Color fundus image, Remidio FOP fundus camera
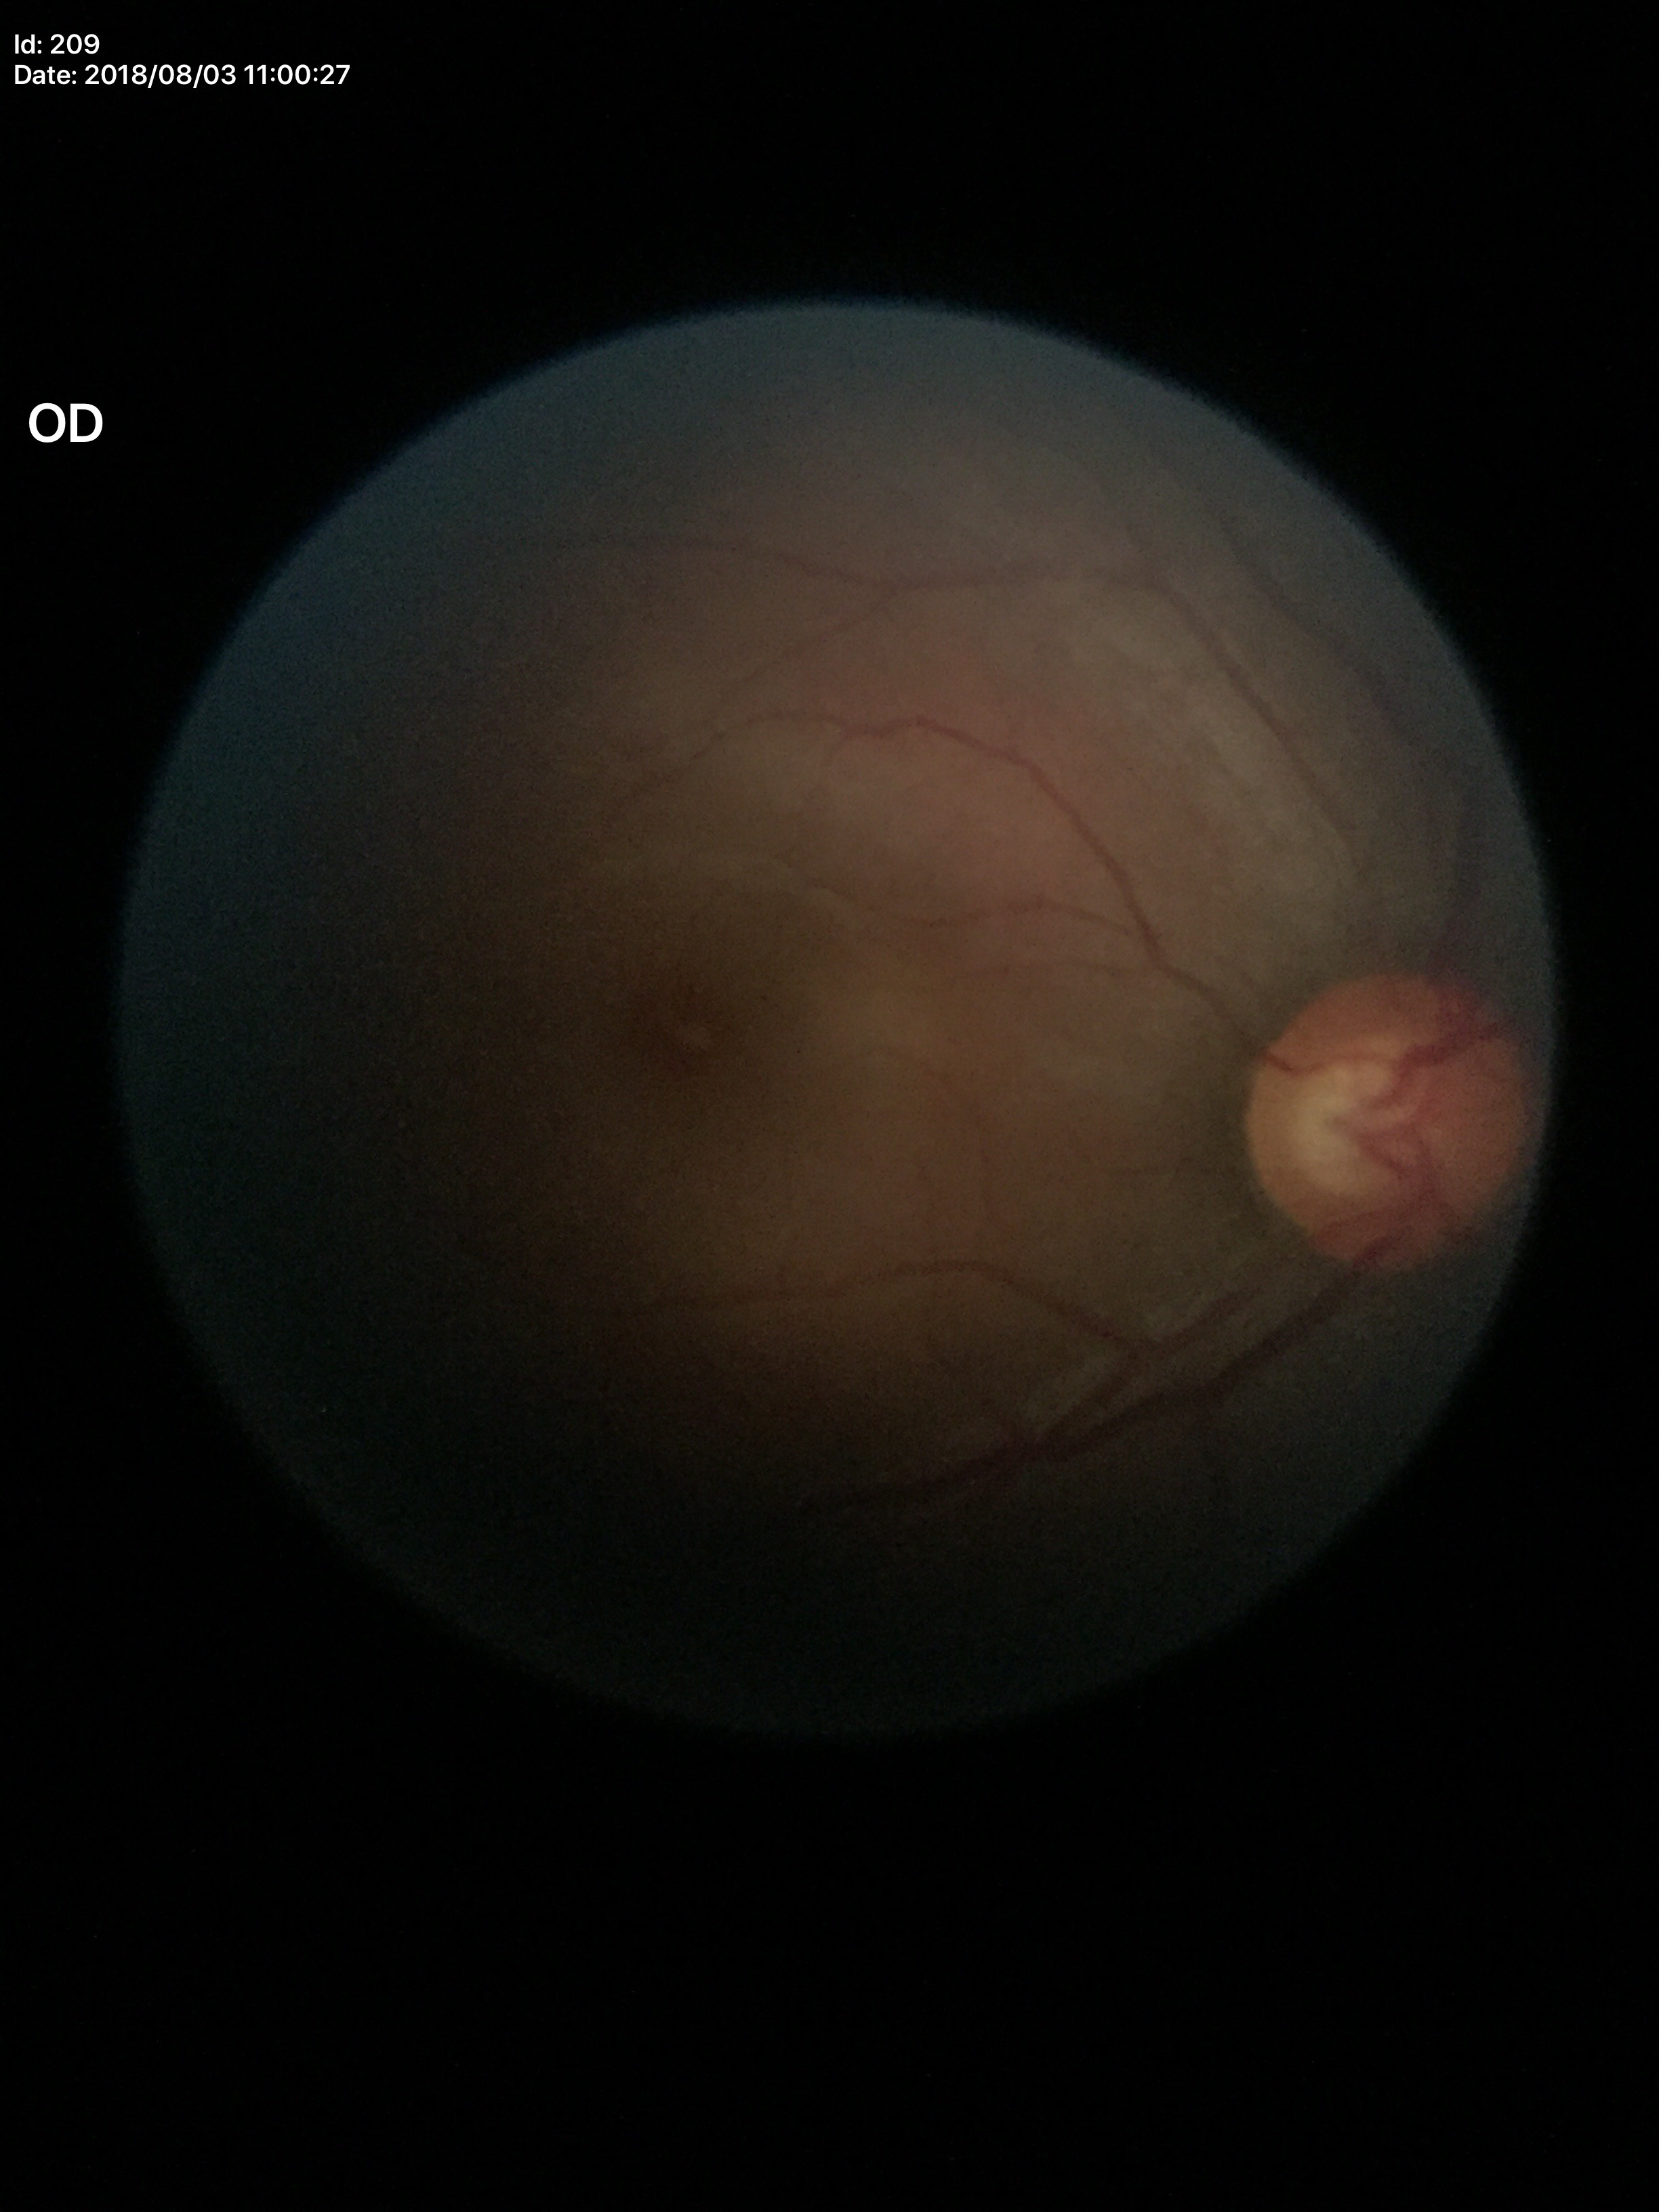 vertical cup-to-disc ratio: 0.57, Glaucoma impression: negative (1/5 graders called glaucoma suspect), area cup-to-disc ratio: 0.32.